Captured with the Phoenix ICON (100° field of view). 1240x1240px. Wide-field fundus image from infant ROP screening — 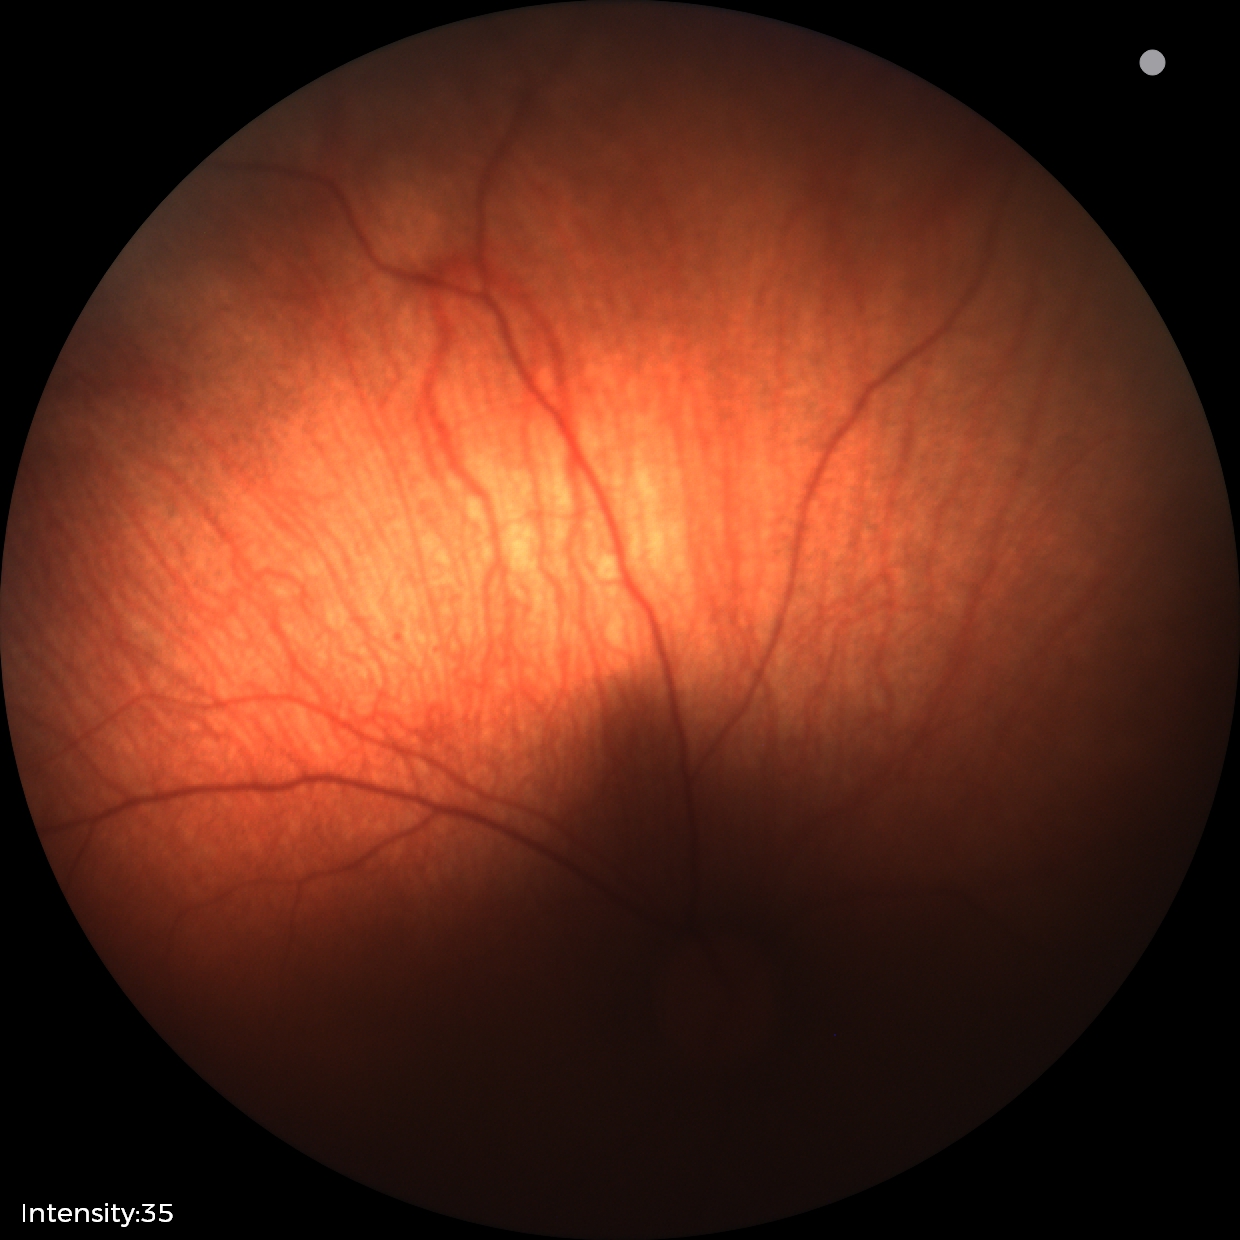
Screening examination diagnosed as physiological.